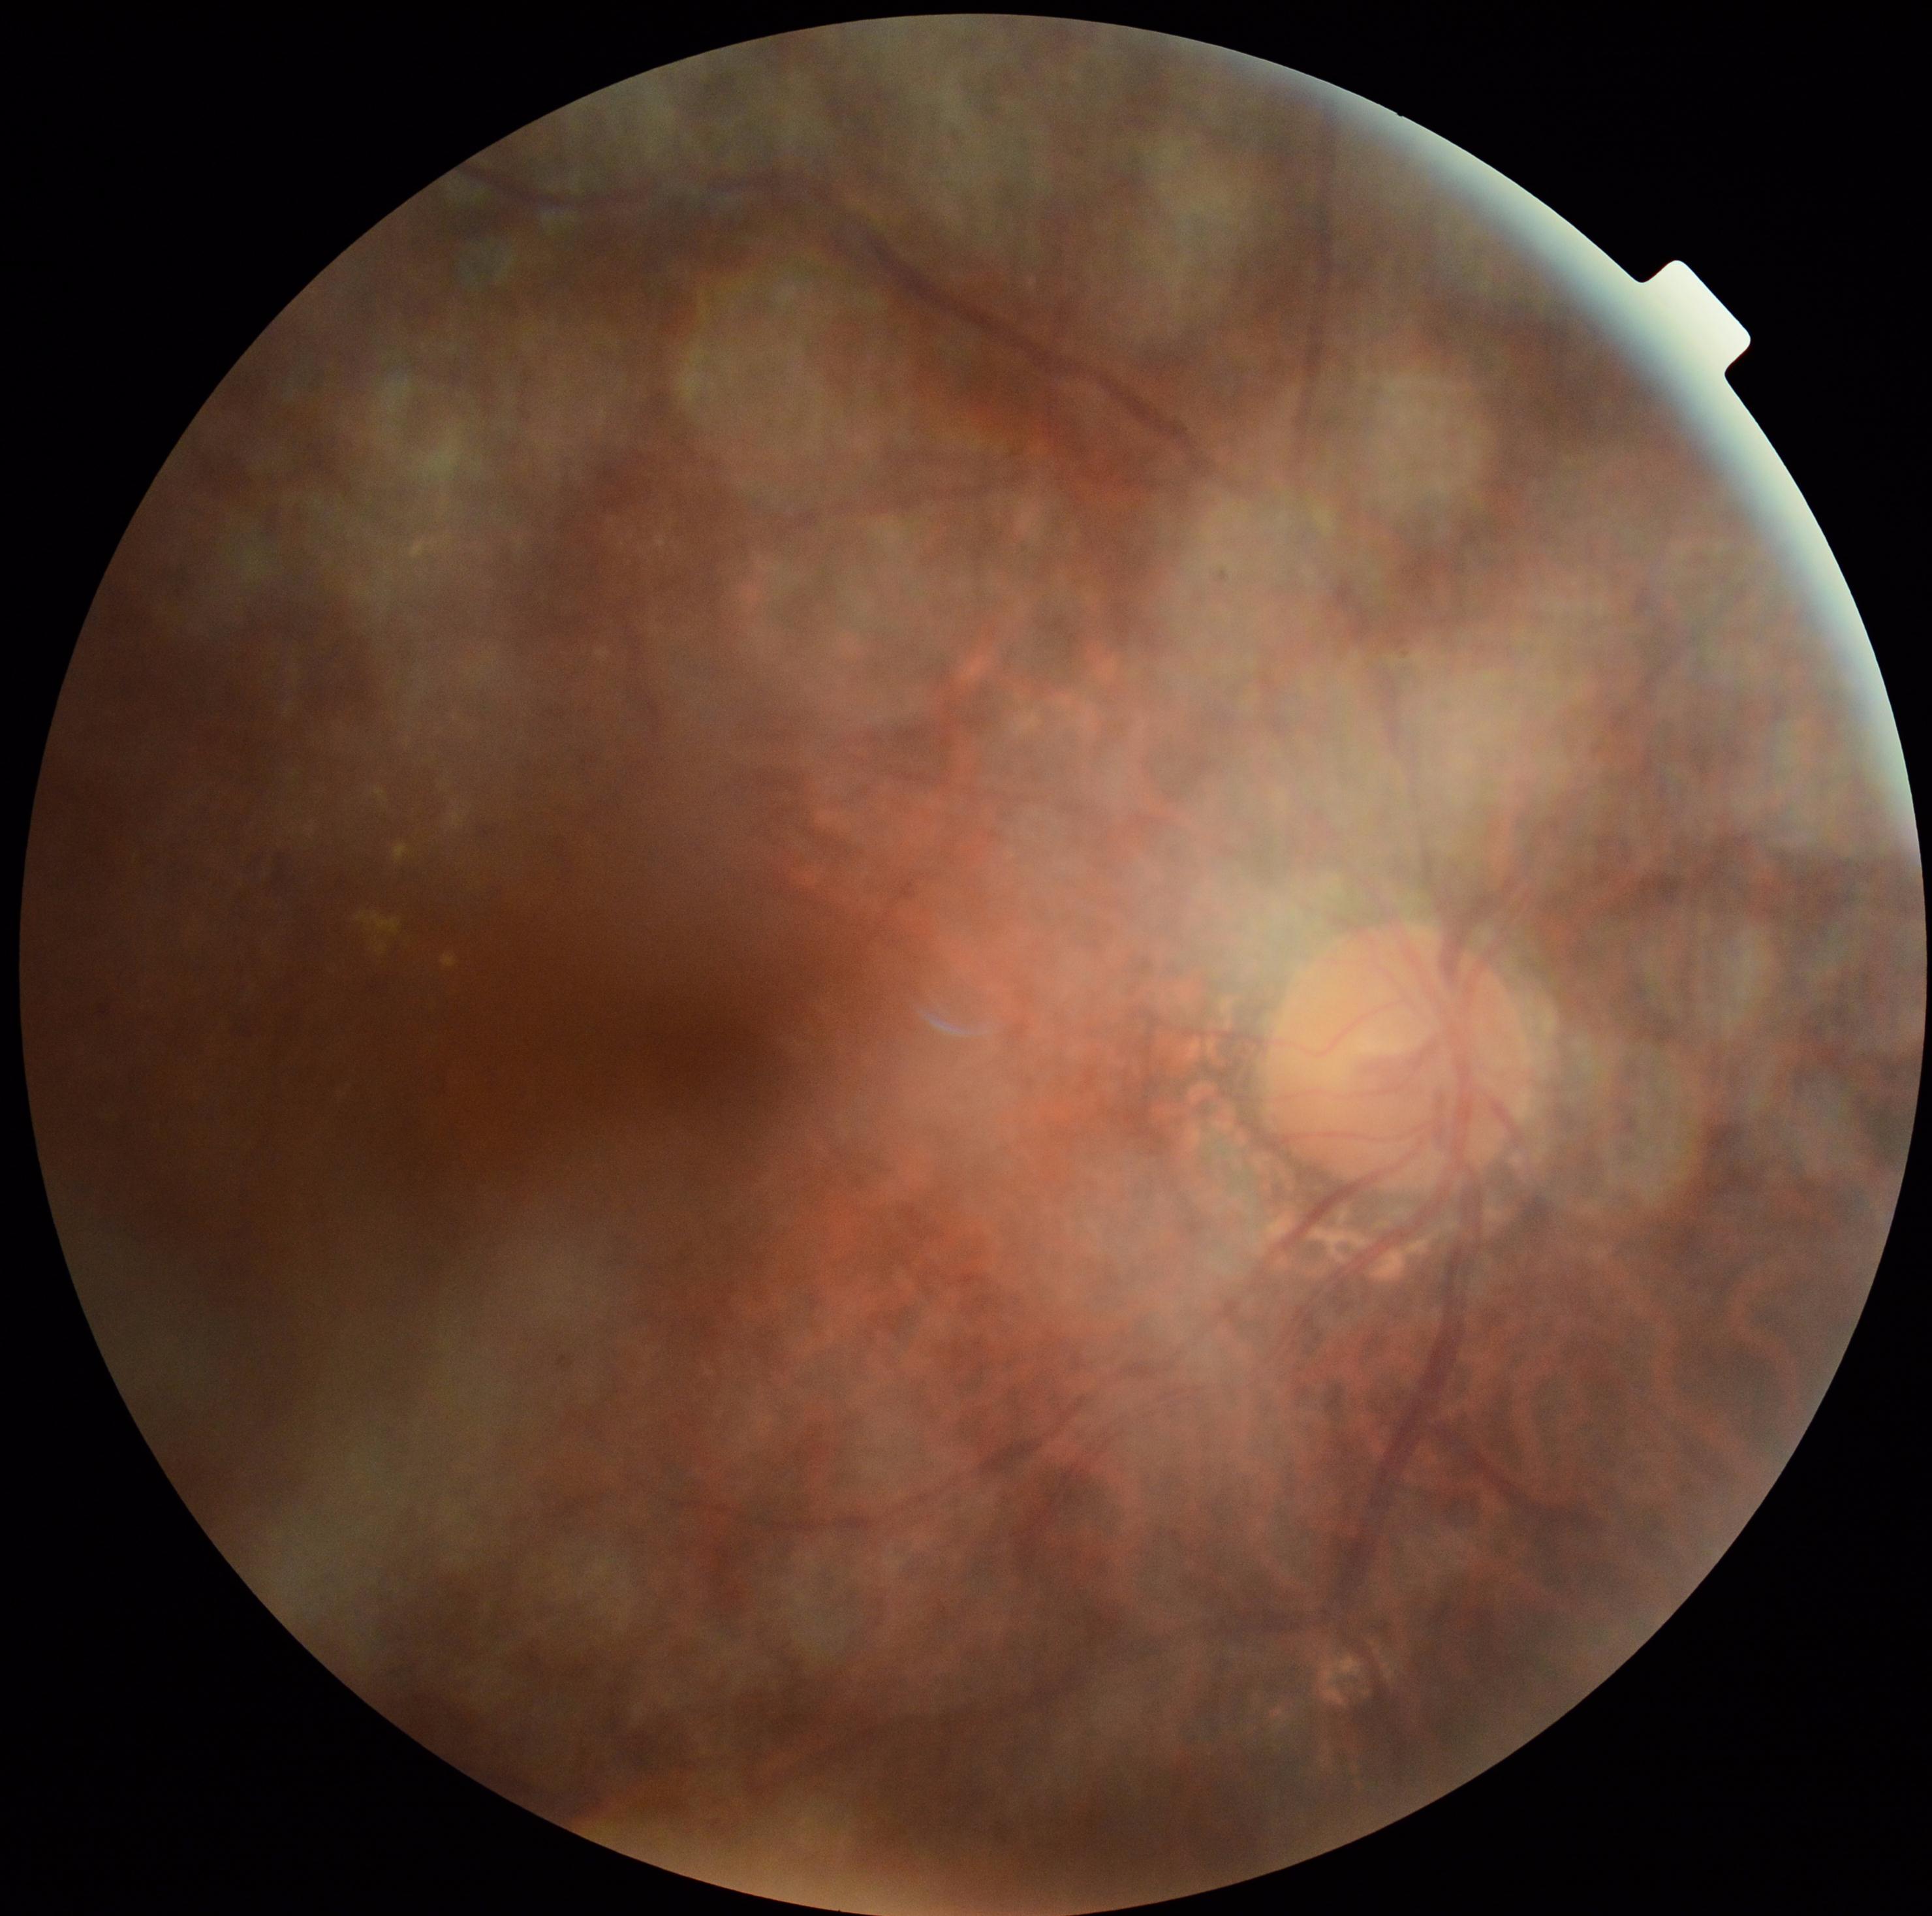

DR: moderate NPDR (grade 2).